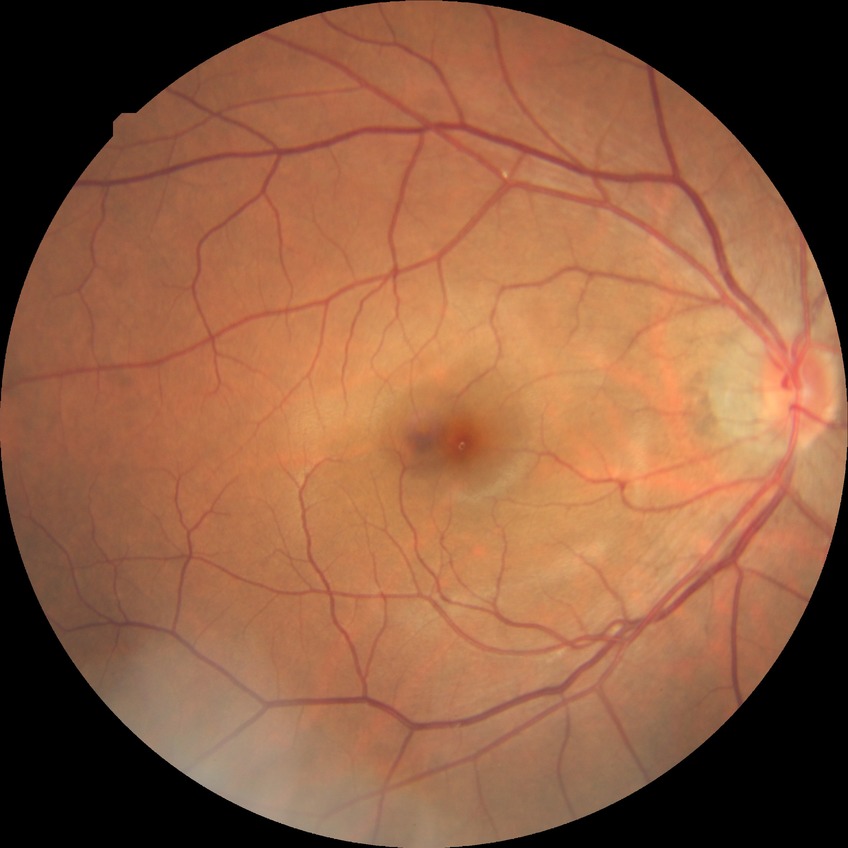
diabetic retinopathy severity: no diabetic retinopathy.